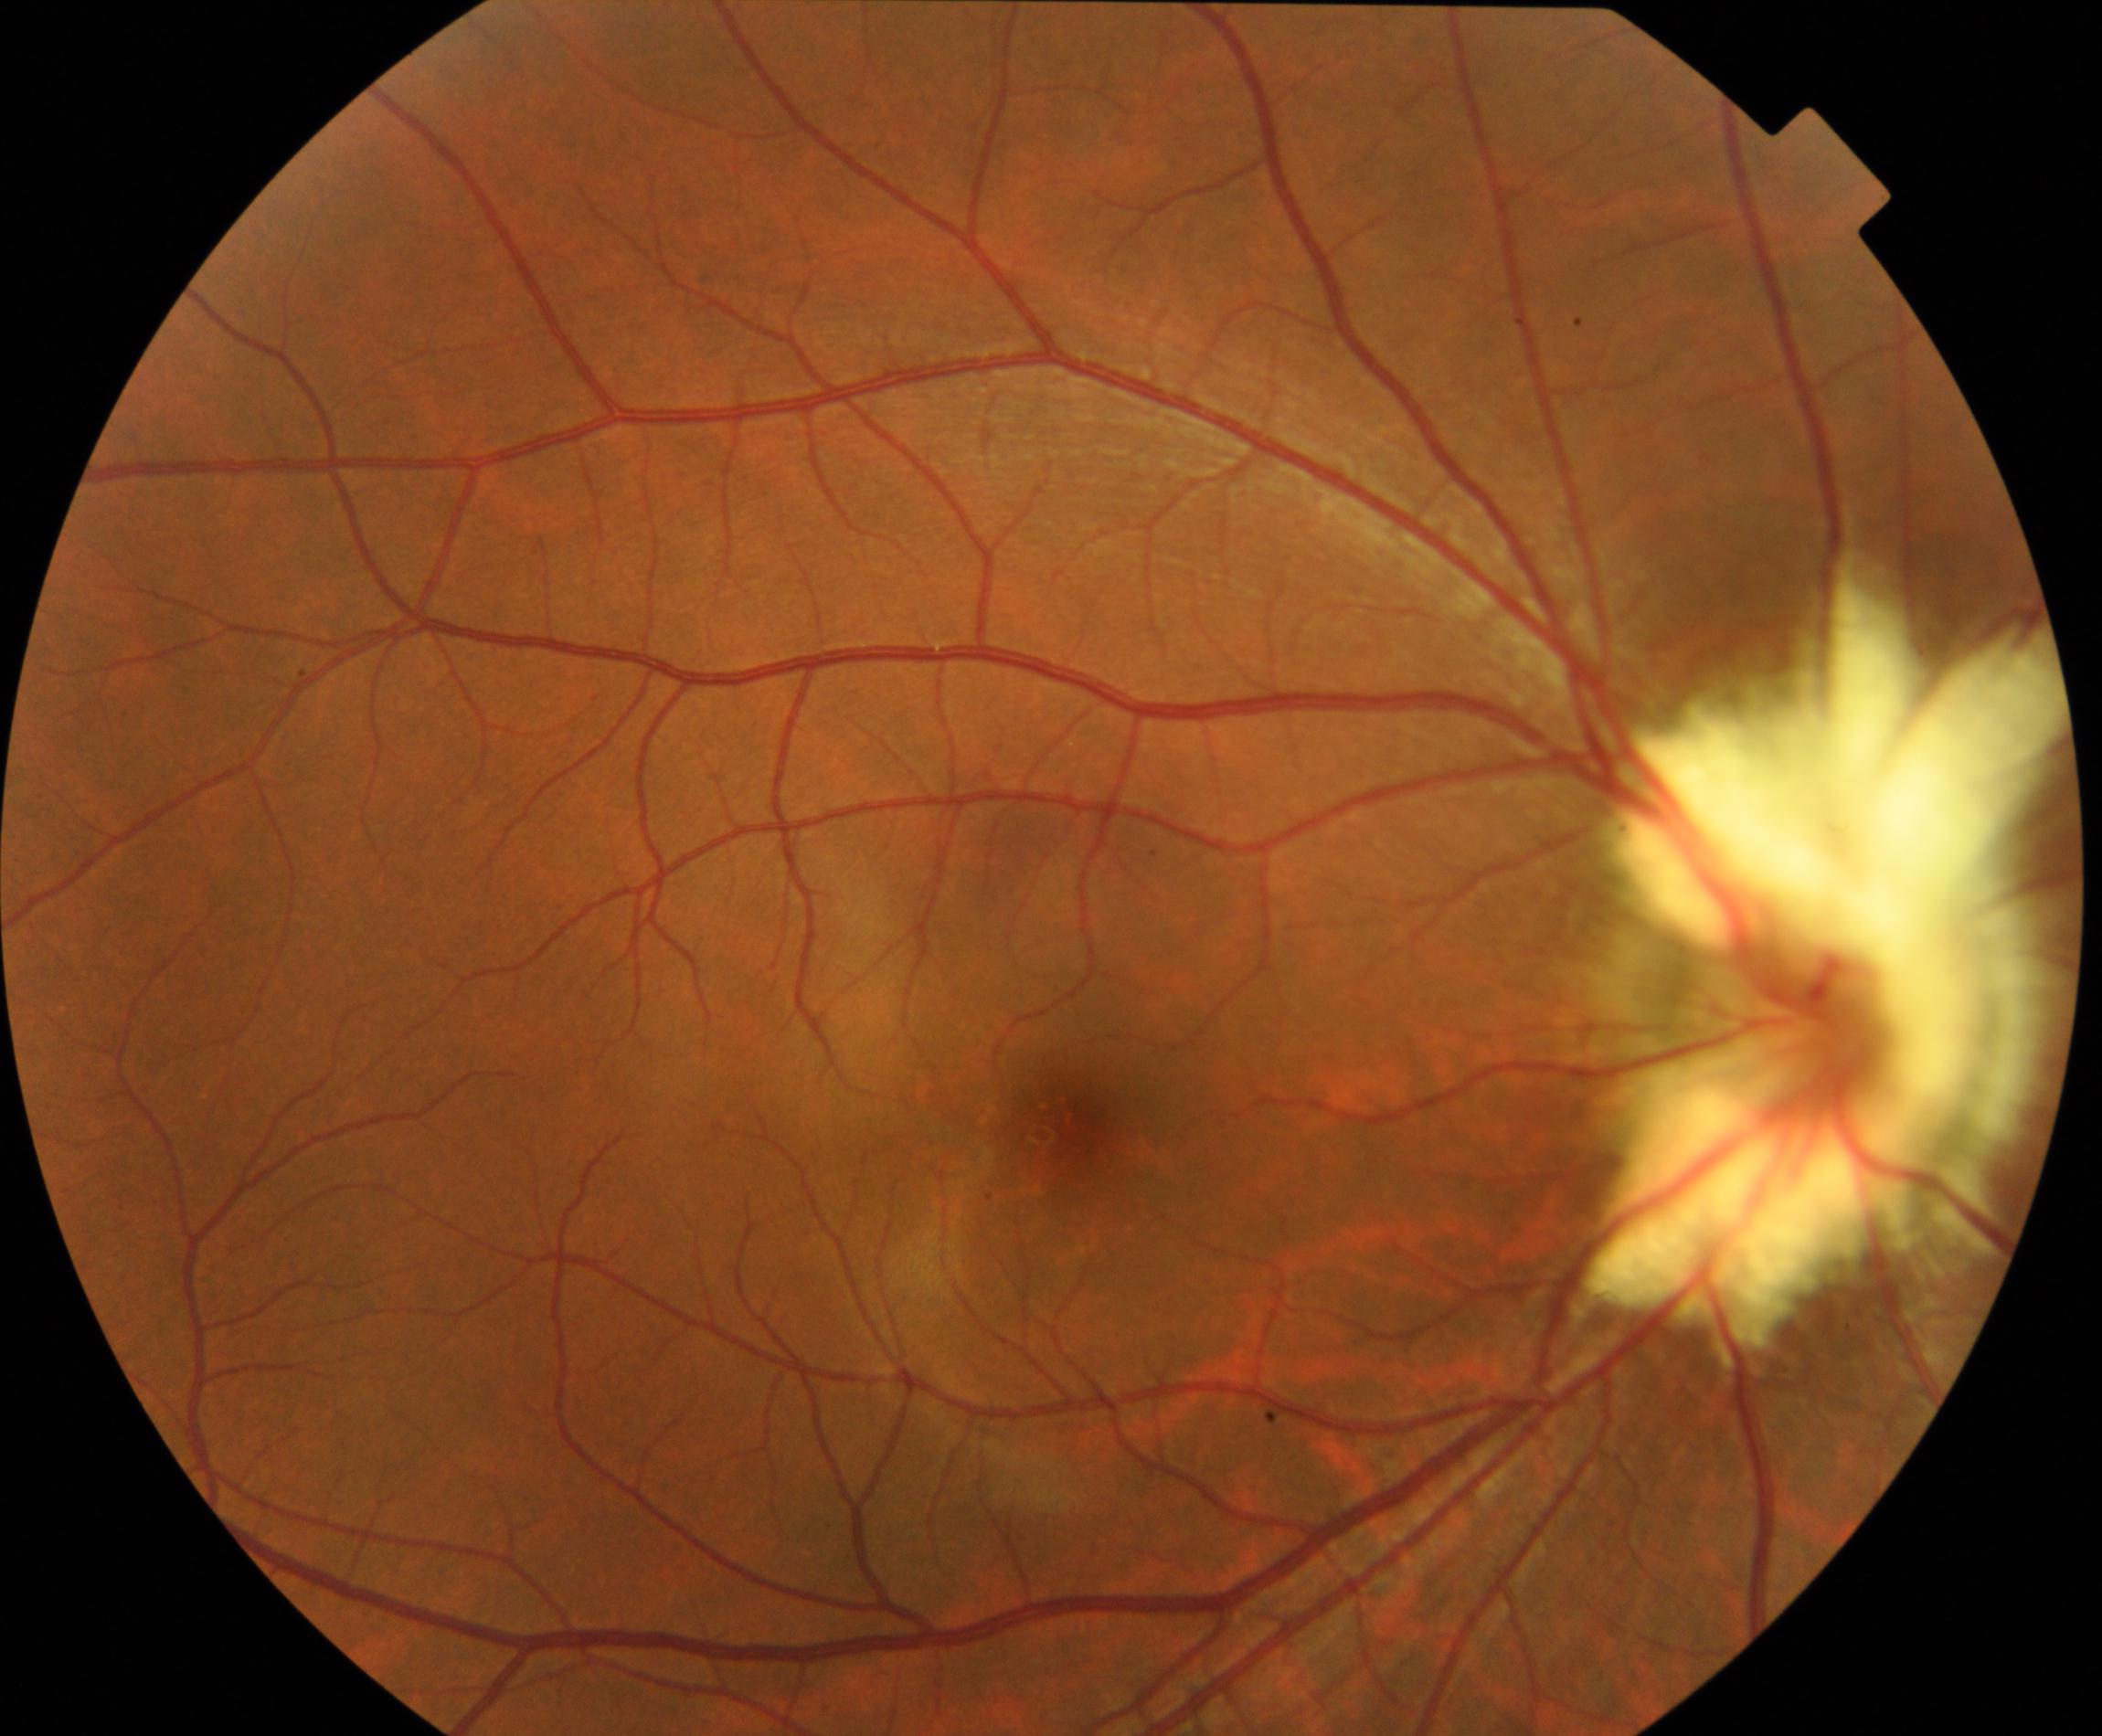
Diagnosis: myelinated nerve fibers. Typically showing whitish striated patches with feathery borders that obscure retinal vessels.